Diabetic retinopathy graded by the modified Davis classification; nonmydriatic.
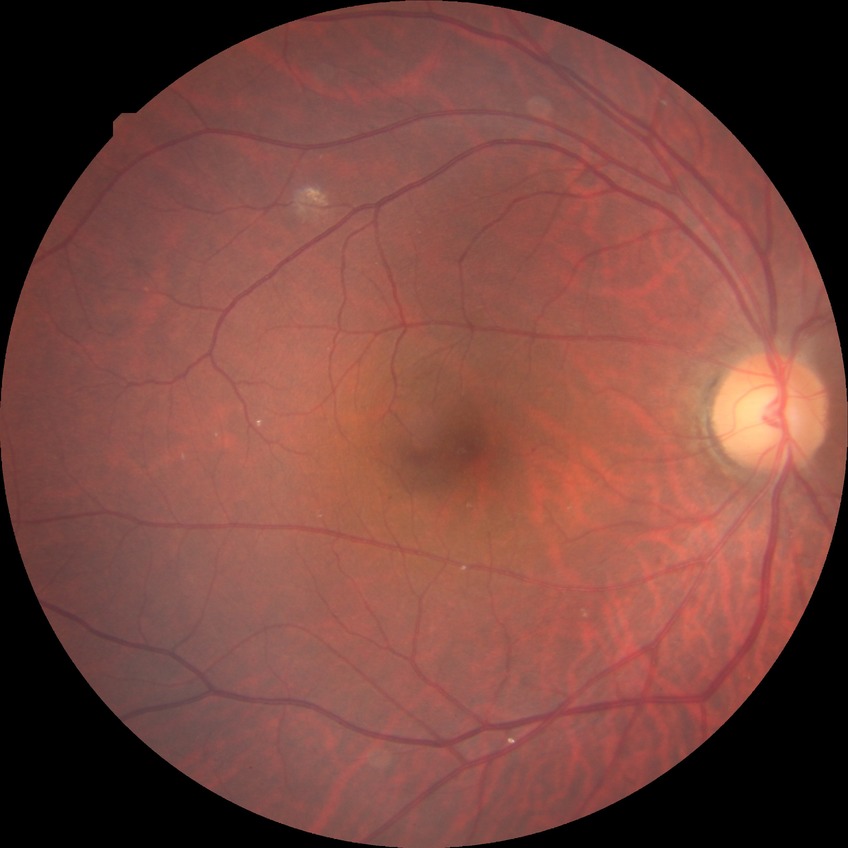

Diabetic retinopathy (DR) is no diabetic retinopathy (NDR).